848 x 848 pixels; nonmydriatic — 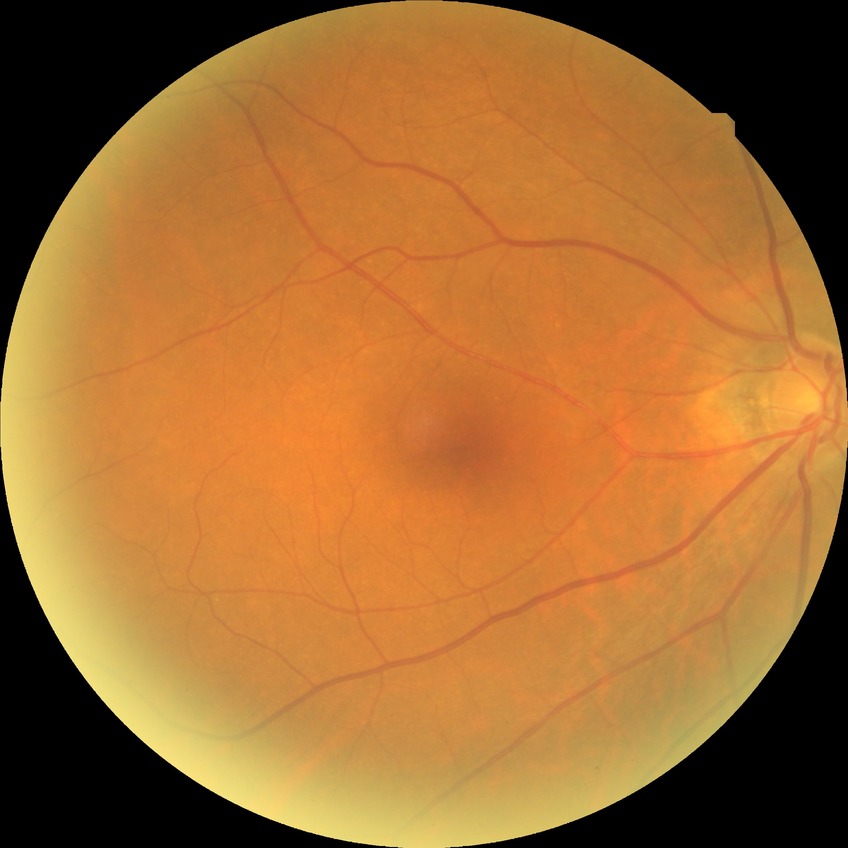

davis_grade: no diabetic retinopathy